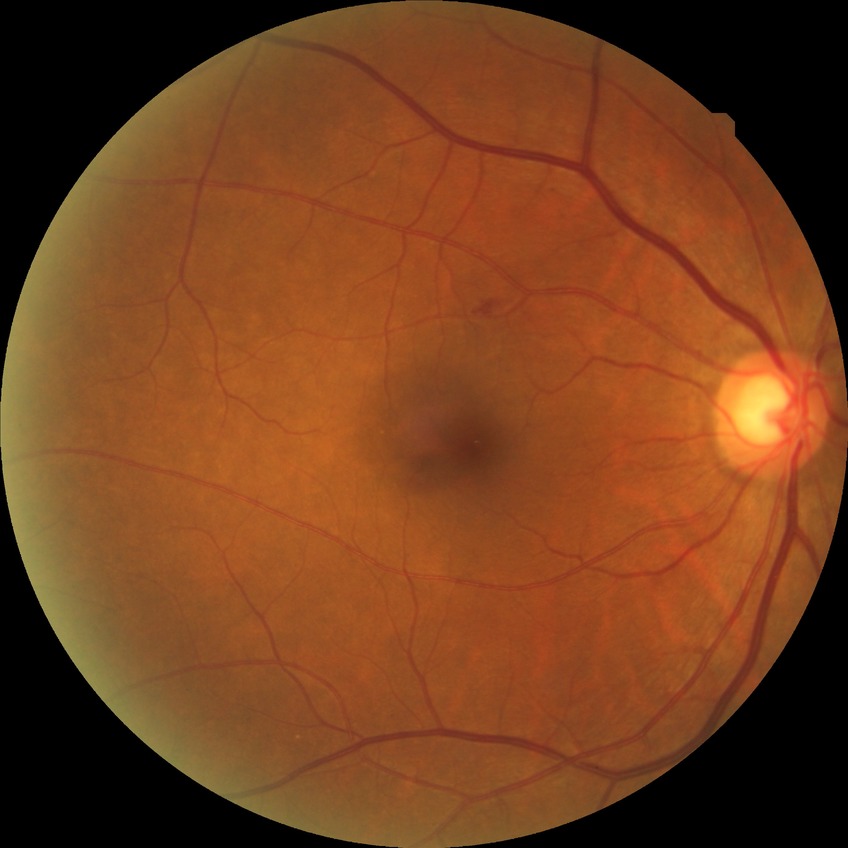
Diabetic retinopathy (DR): NDR (no diabetic retinopathy).